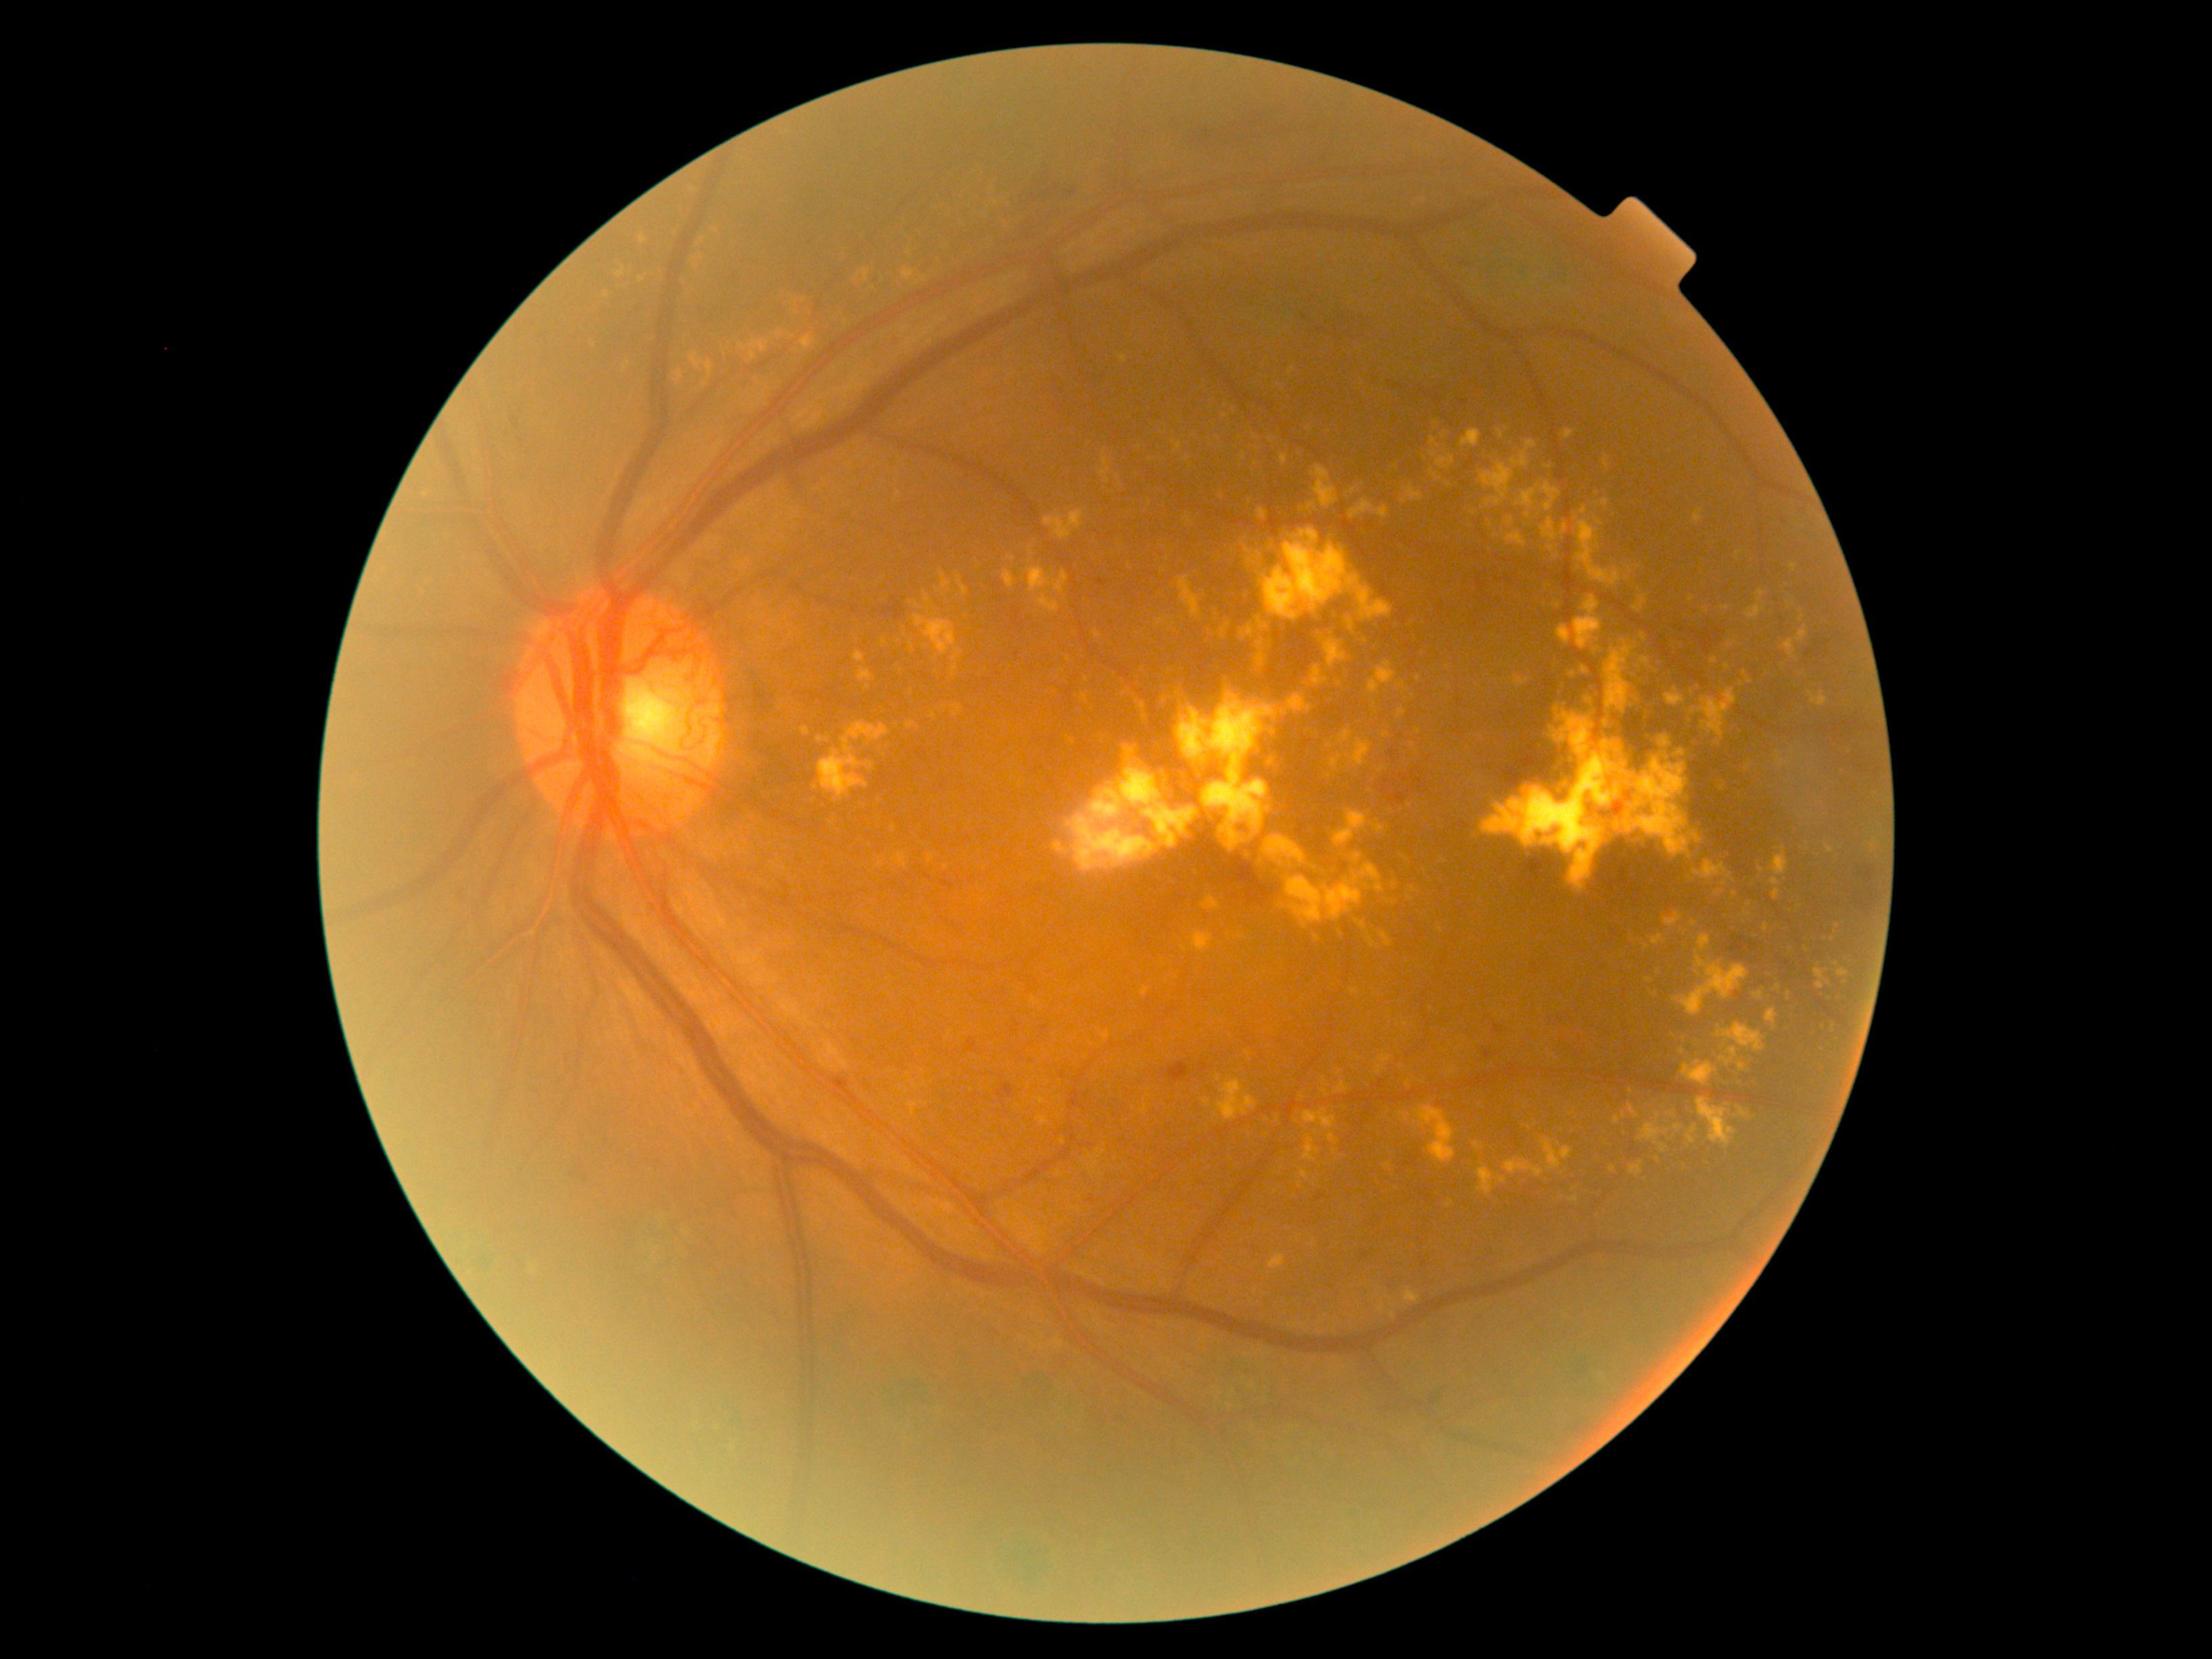

DR stage: grade 4 (PDR)
A subset of detected lesions:
EXs (partial) = bbox(1317, 634, 1348, 668) | bbox(586, 335, 596, 352) | bbox(1675, 954, 1749, 1016) | bbox(1104, 737, 1113, 743) | bbox(1630, 1161, 1643, 1177) | bbox(1638, 937, 1643, 945) | bbox(1675, 1124, 1684, 1132) | bbox(1401, 485, 1425, 505) | bbox(1641, 657, 1650, 666) | bbox(1641, 634, 1647, 642) | bbox(1118, 353, 1128, 364) | bbox(1775, 753, 1793, 769)
EXs (small, approximate centers) near Point(945, 867) | Point(1152, 459) | Point(1254, 464) | Point(1583, 511) | Point(1316, 1133) | Point(1596, 650) | Point(1398, 904) | Point(1449, 484)